Color fundus image, 45-degree field of view — 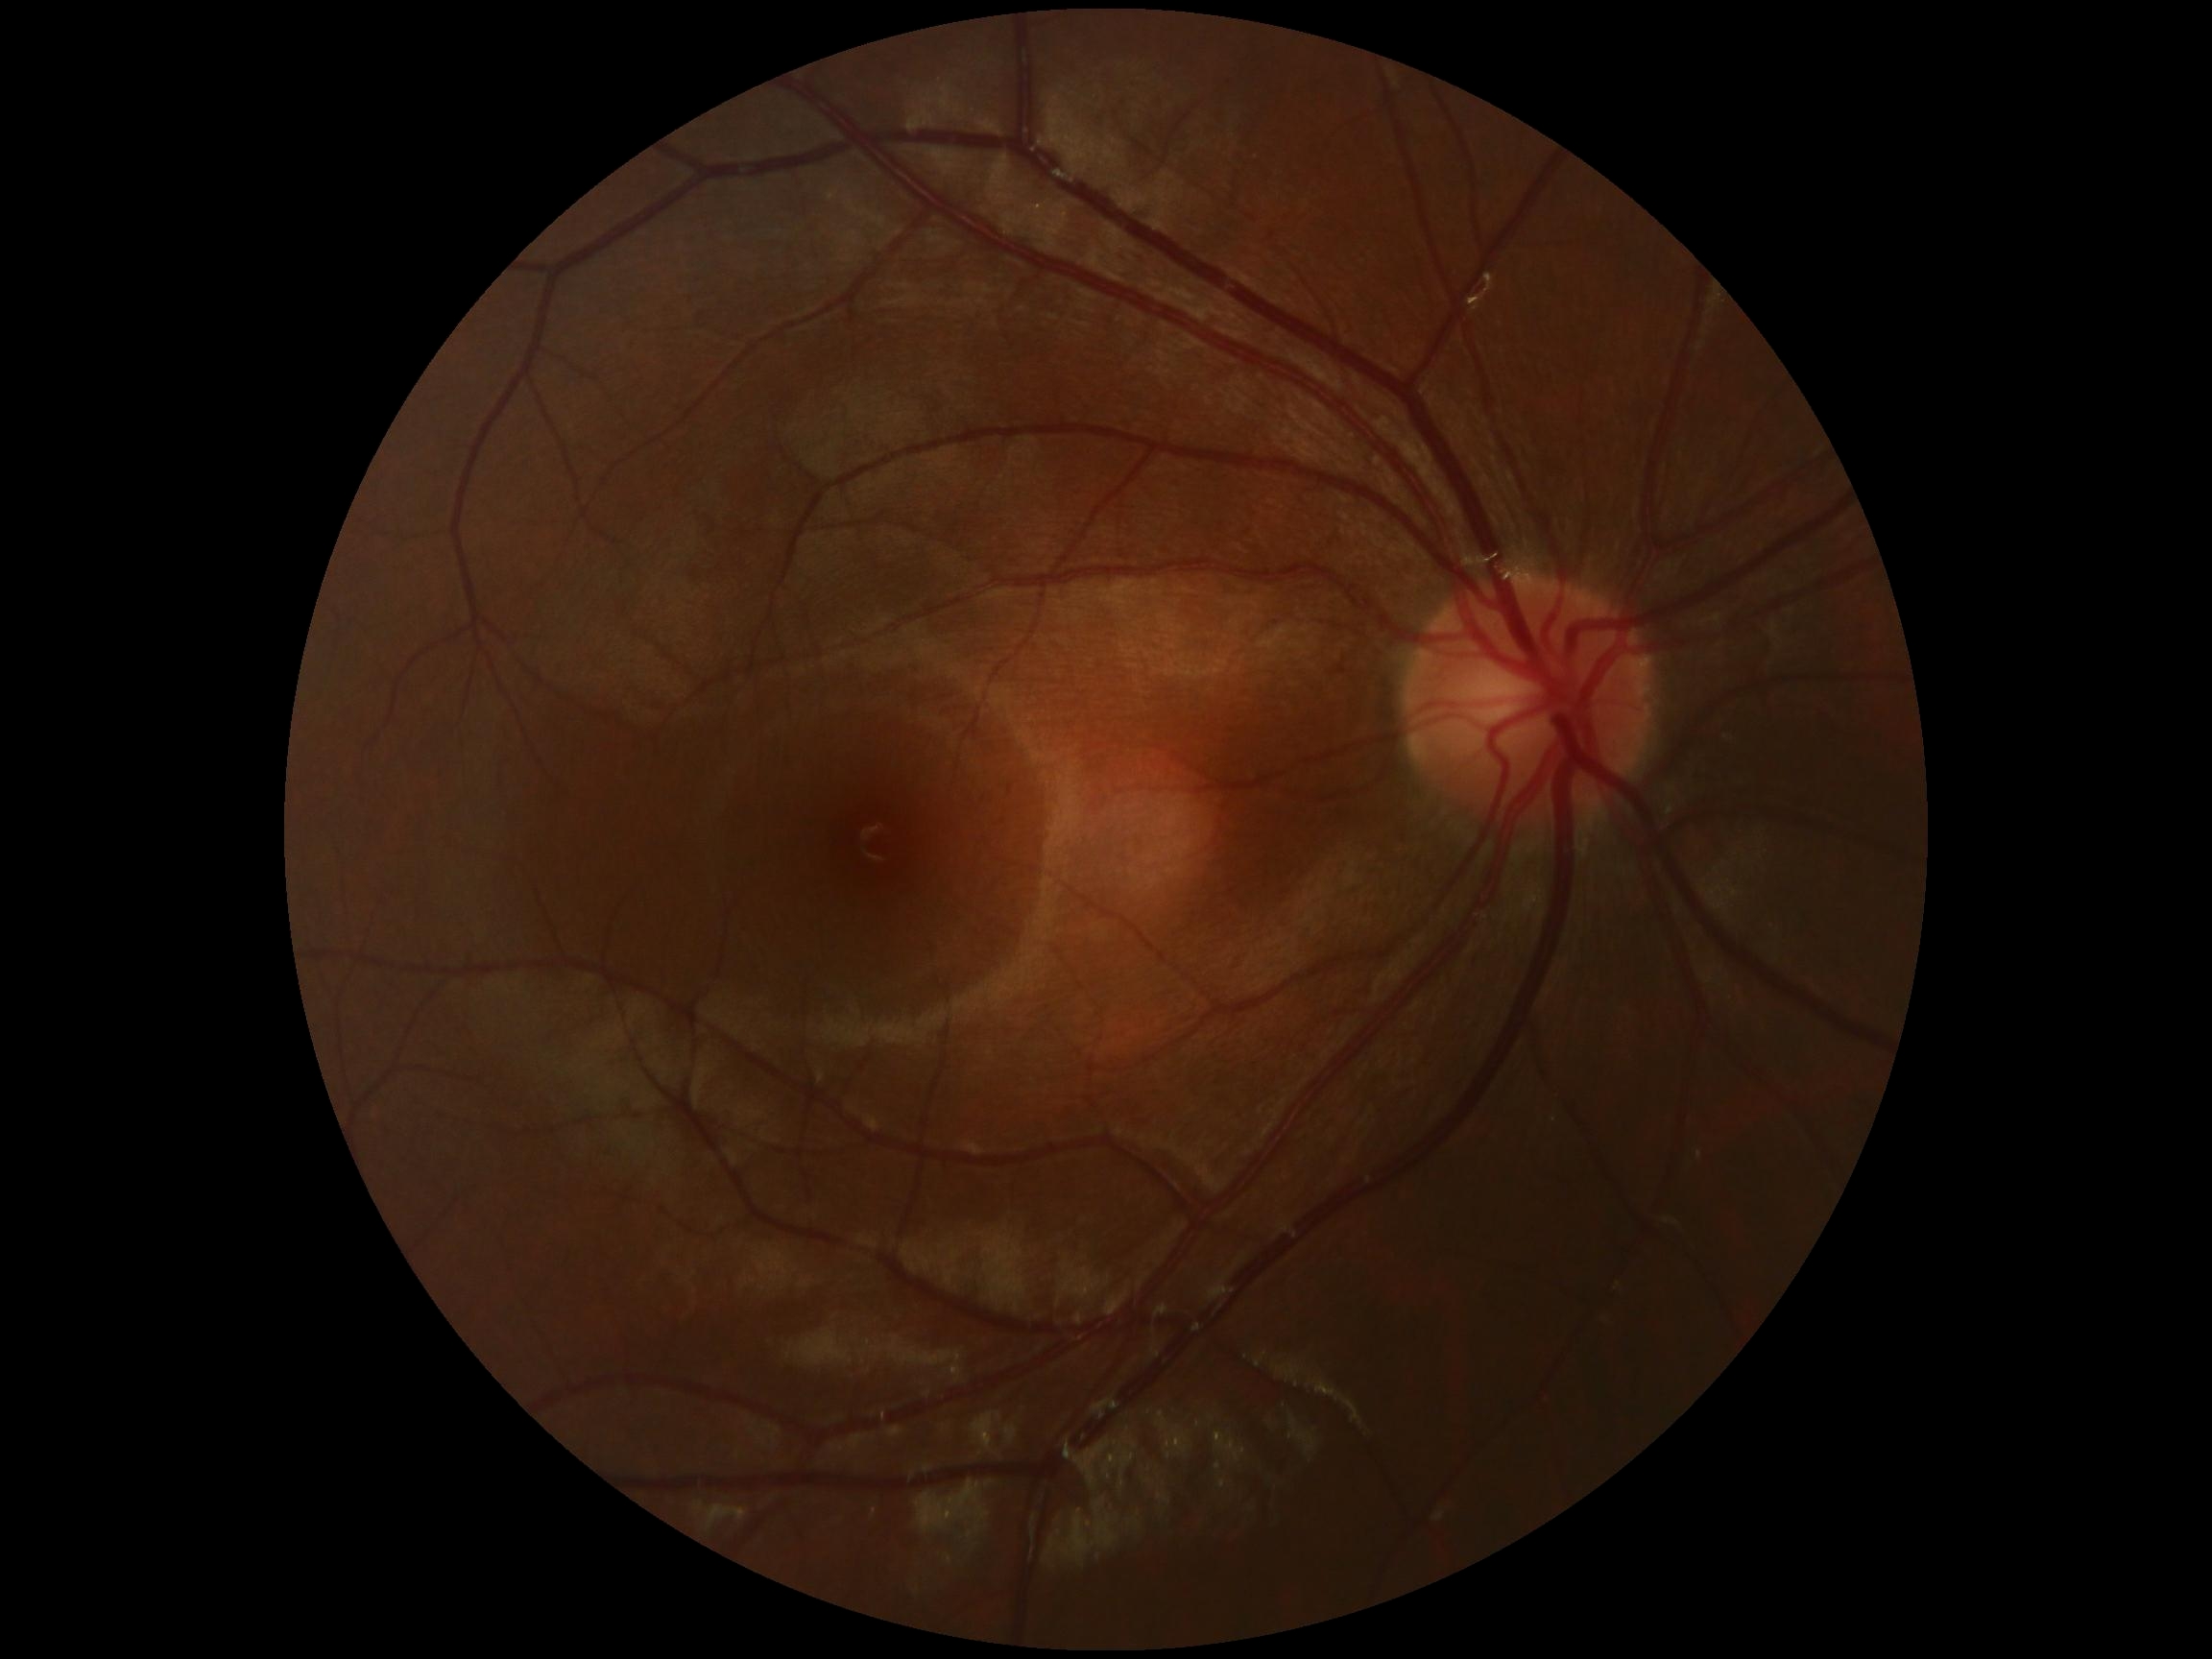
Diabetic retinopathy: grade 0 (no apparent retinopathy).